2089x1764px: 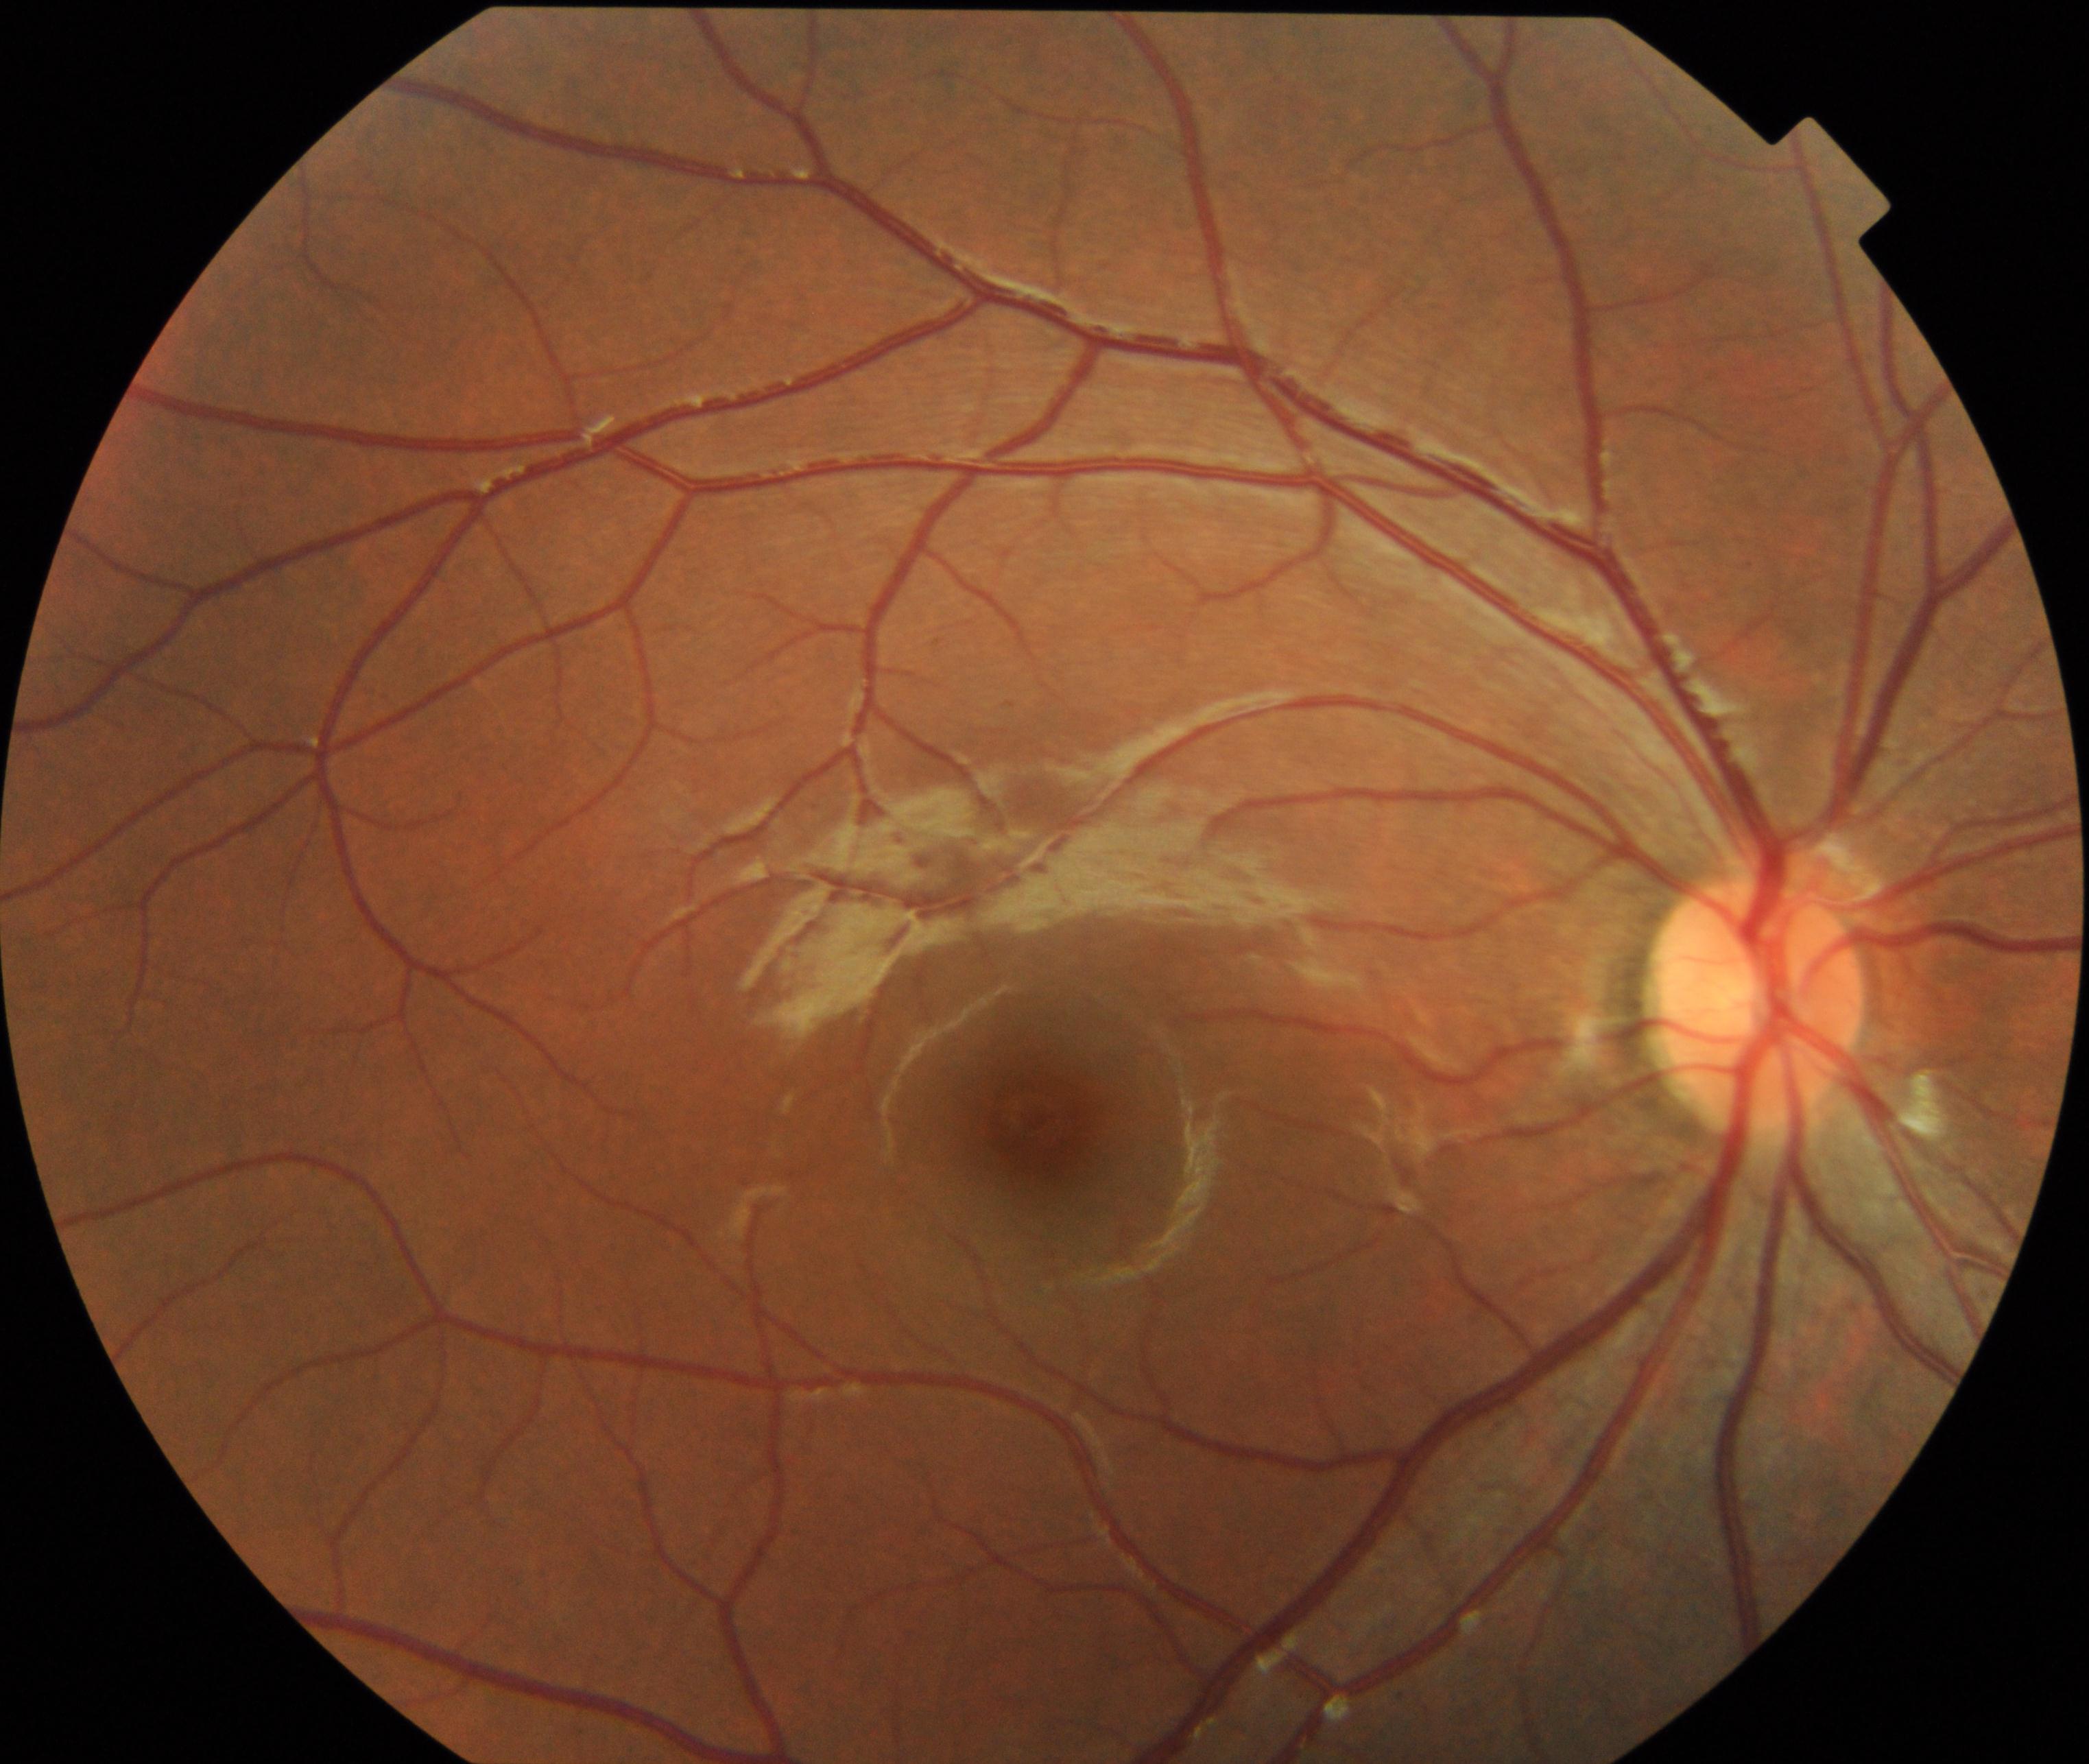 Normal fundus appearance.